Without pupil dilation. 848x848px. Camera: NIDEK AFC-230. 45° FOV. Modified Davis grading
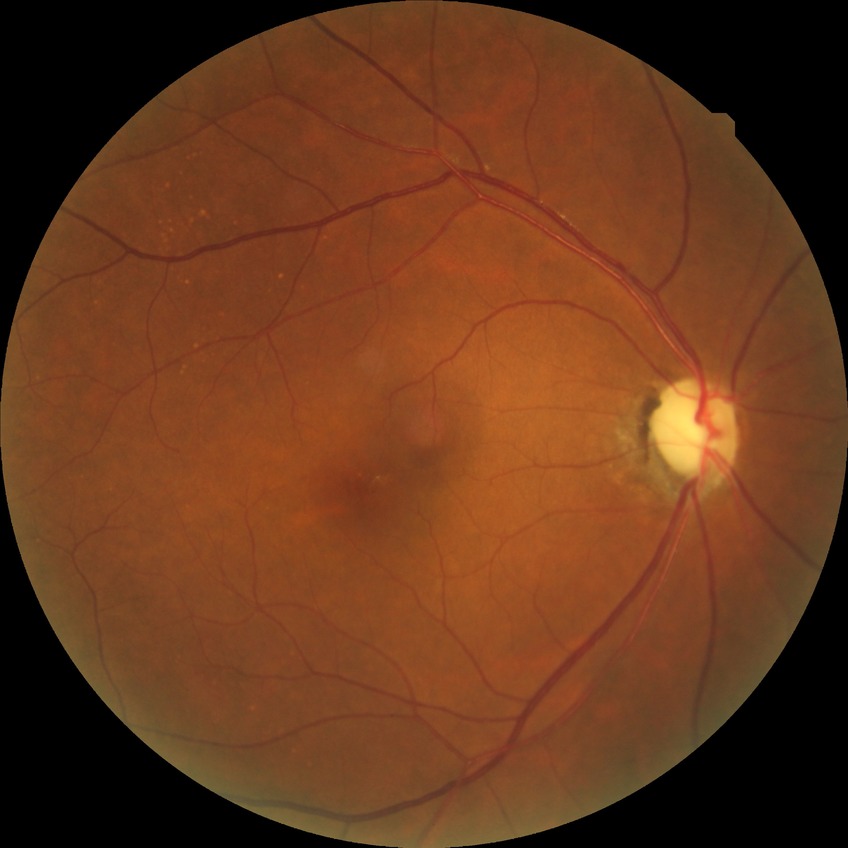 Davis grading=no diabetic retinopathy.